Disc-centered field; fundus photo; 240 x 240 pixels.
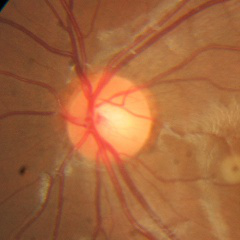 No signs of glaucoma.